865x865. Color fundus photograph centered on the optic disc. 35° FOV before cropping: 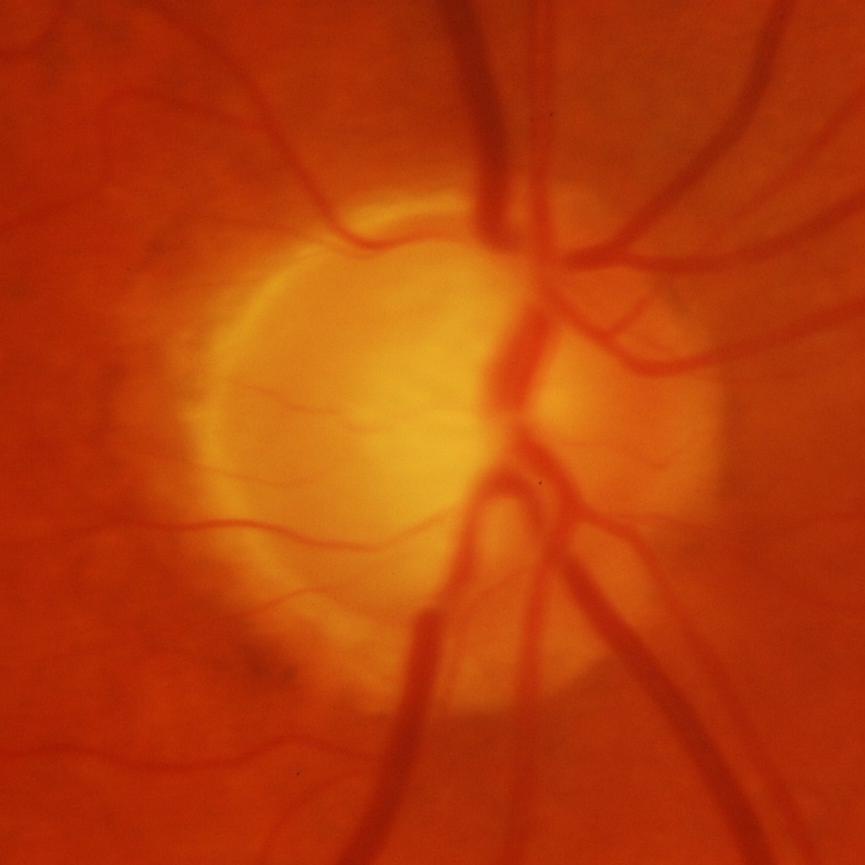 Glaucoma is present. Impression: glaucomatous damage to the optic nerve.